Nonmydriatic fundus photograph. 848 x 848 pixels.
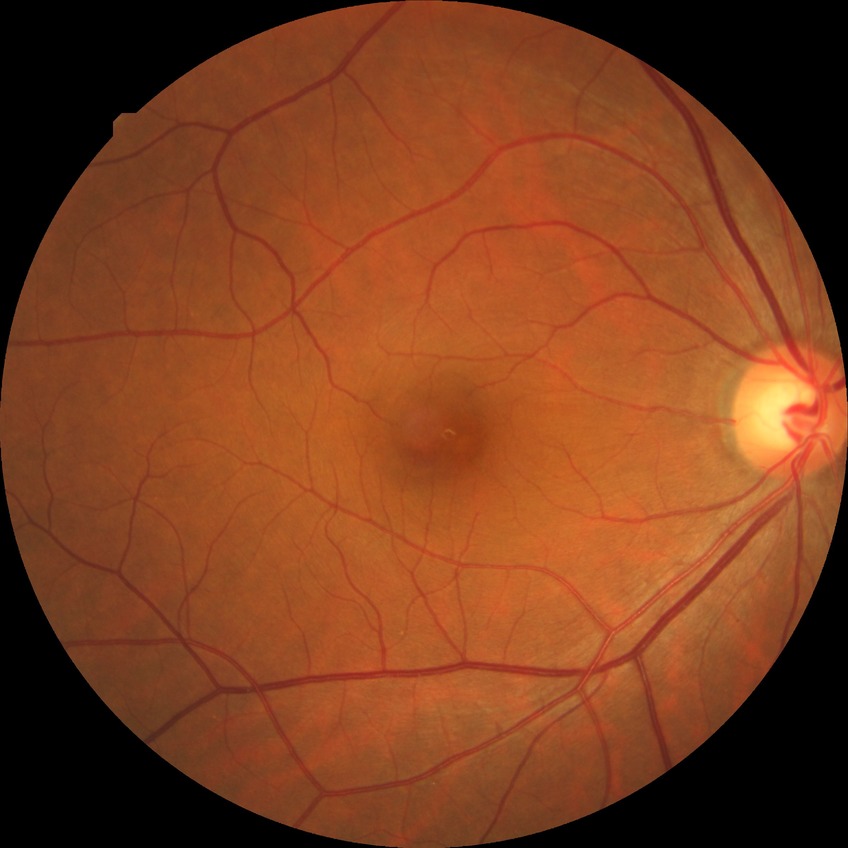
{
  "davis_grade": "no diabetic retinopathy"
}